848x848px — 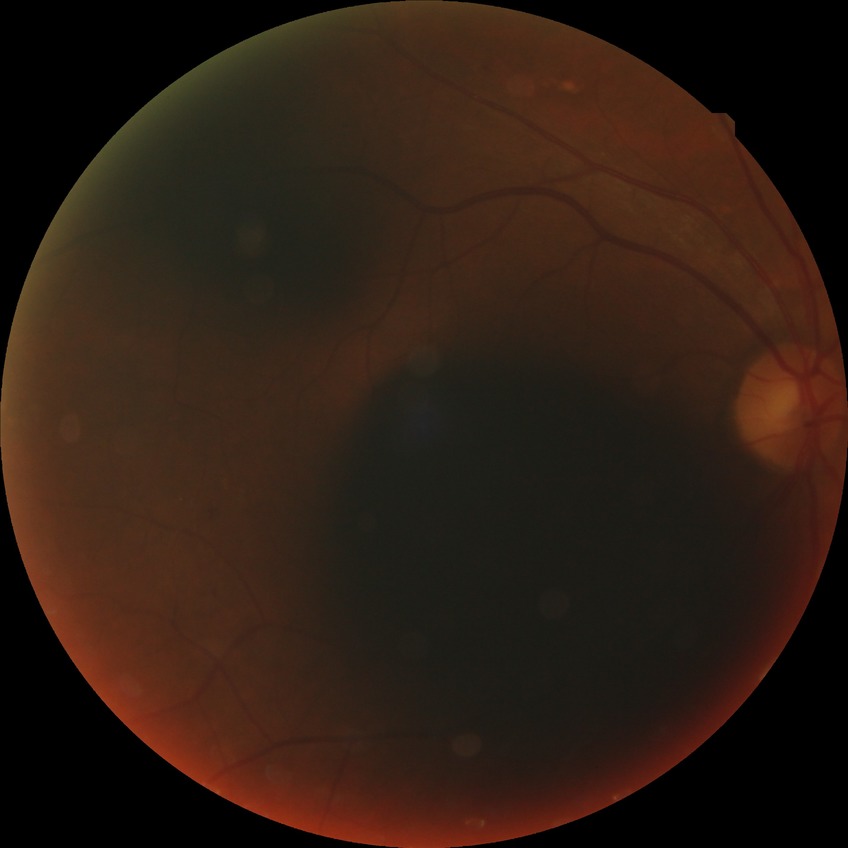

Modified Davis grade is SDR.